Posterior pole photograph.
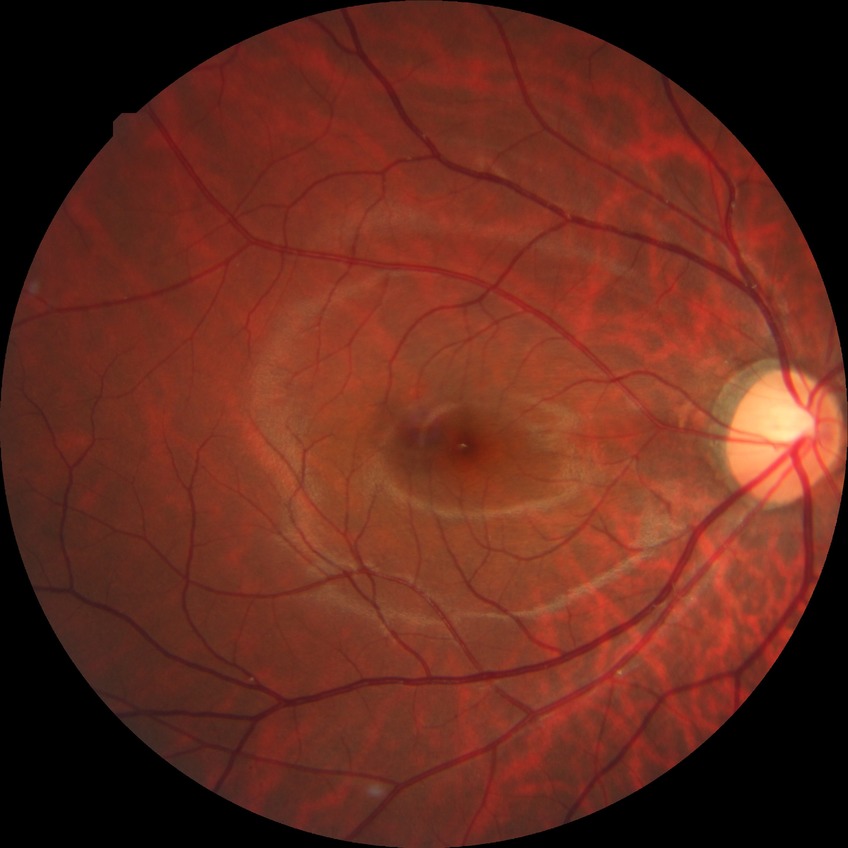
Davis stage: NDR.